Wide-field fundus image from infant ROP screening
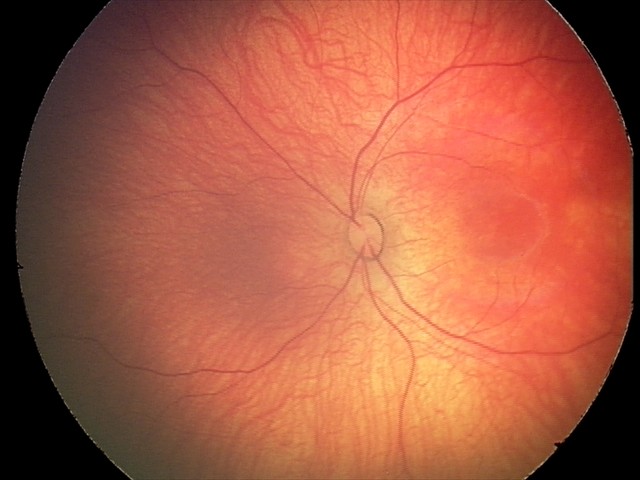

Series diagnosed as retinal hemorrhages.